848x848px:
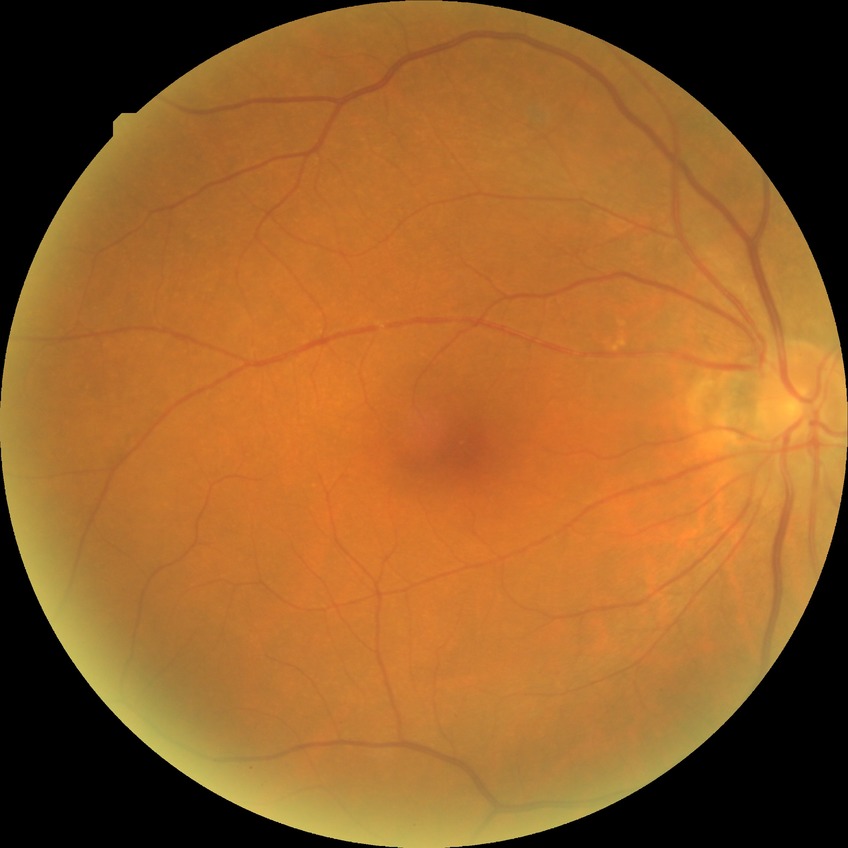
Diabetic retinopathy stage is no diabetic retinopathy.